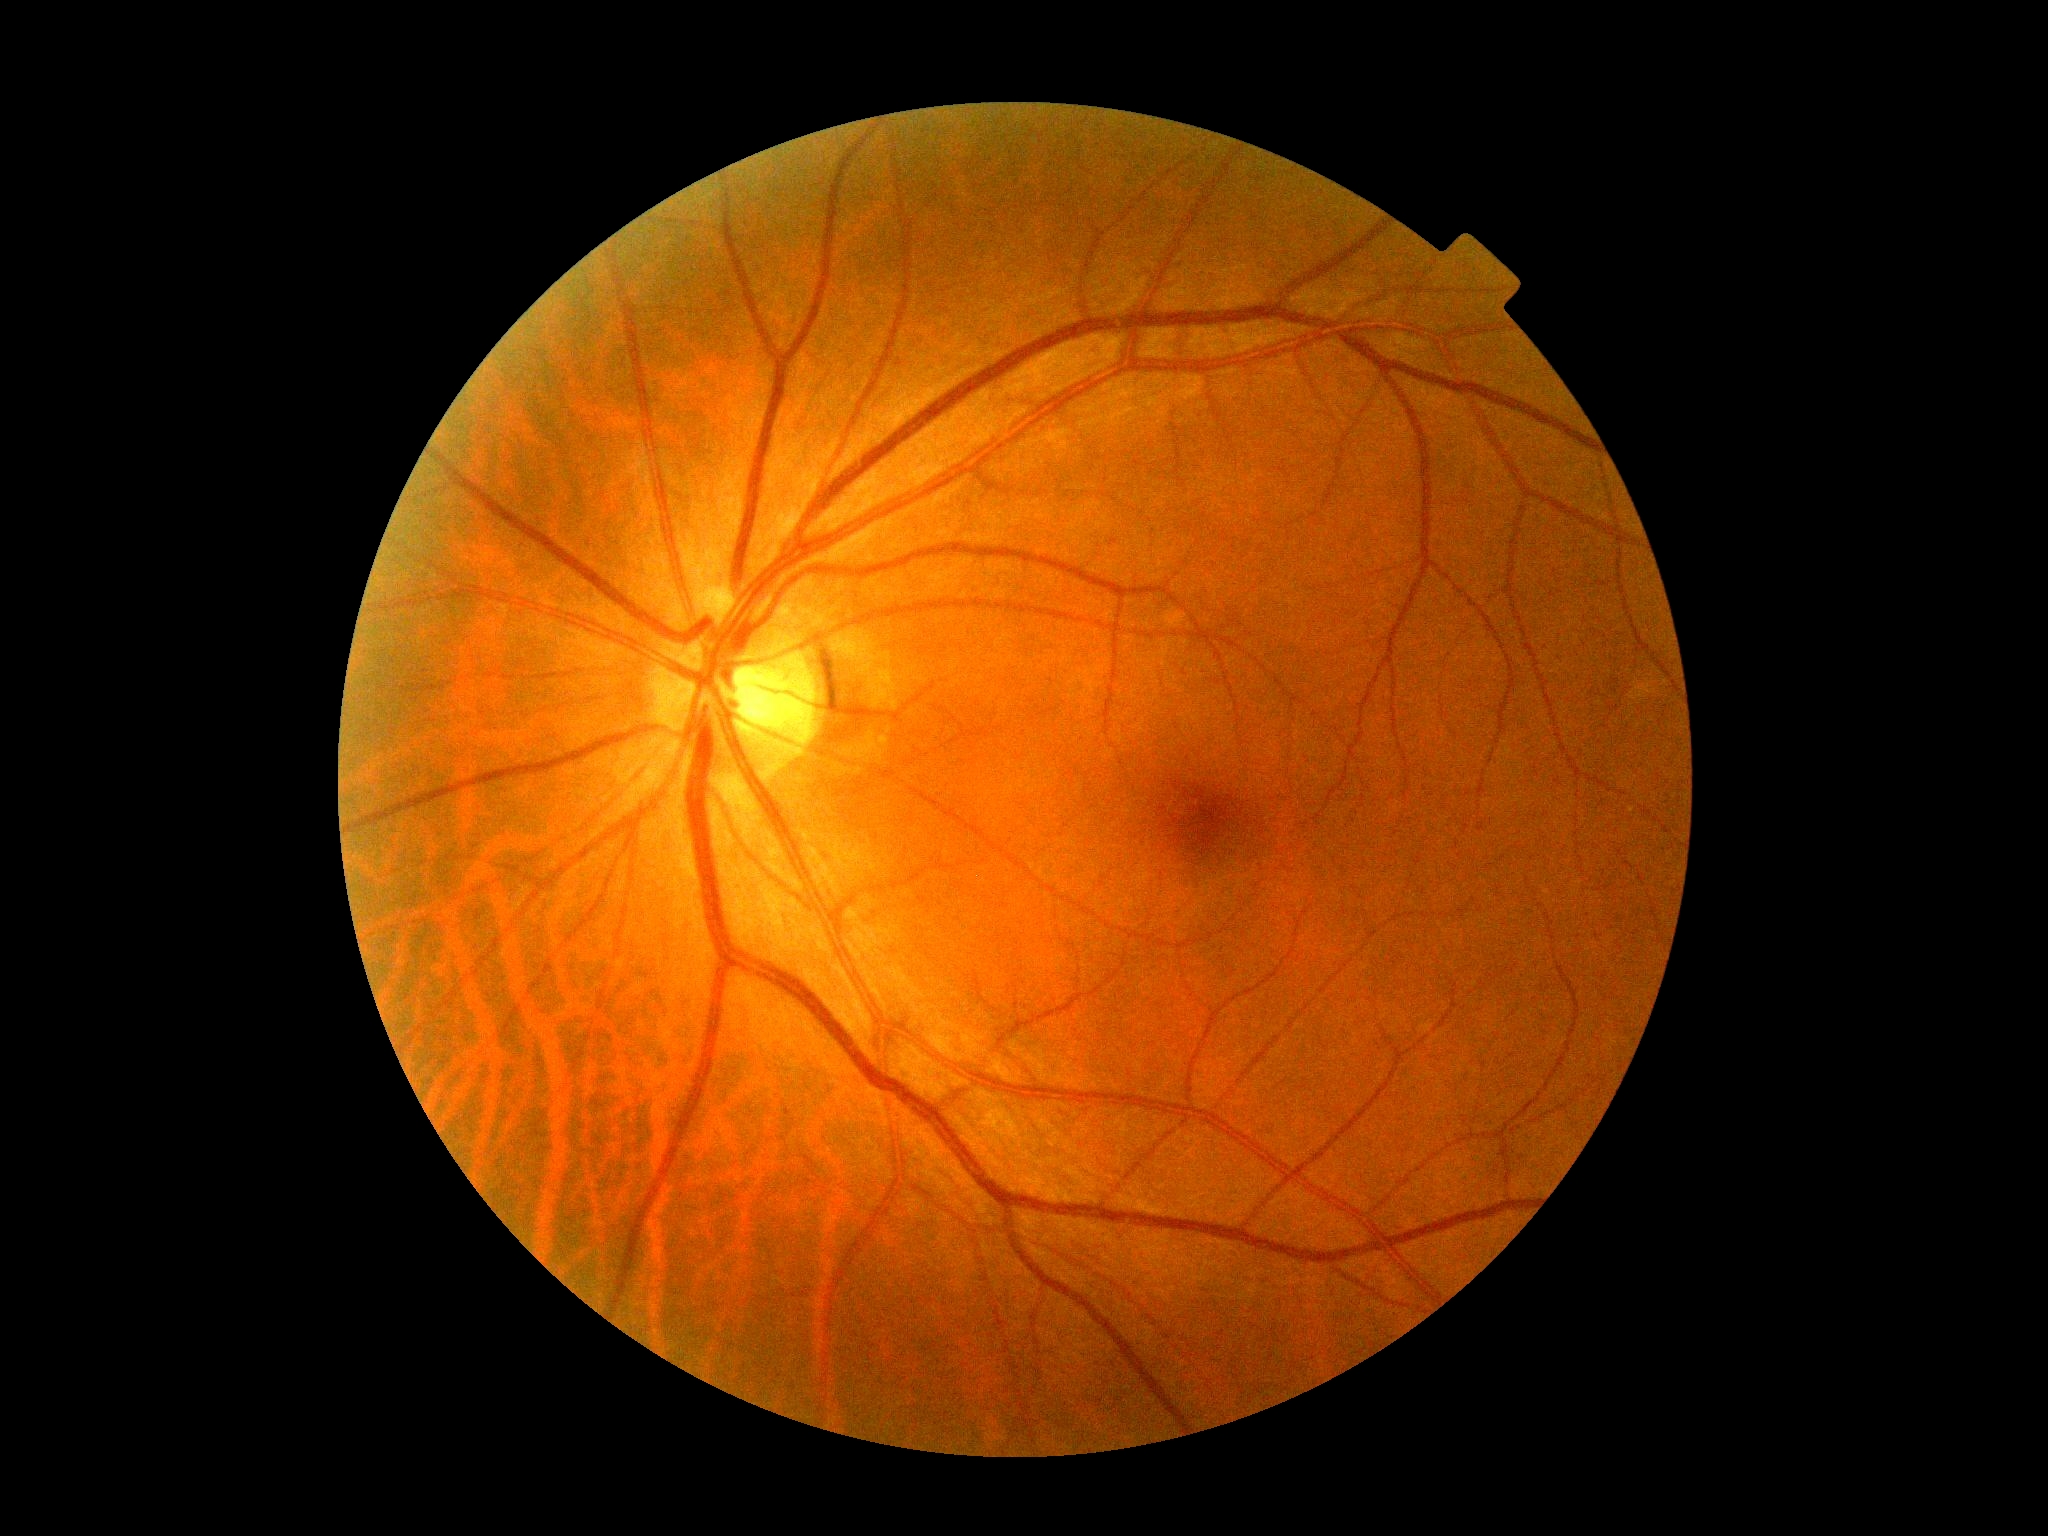 diabetic retinopathy (DR): 0/4.